848 x 848 pixels · Davis DR grading
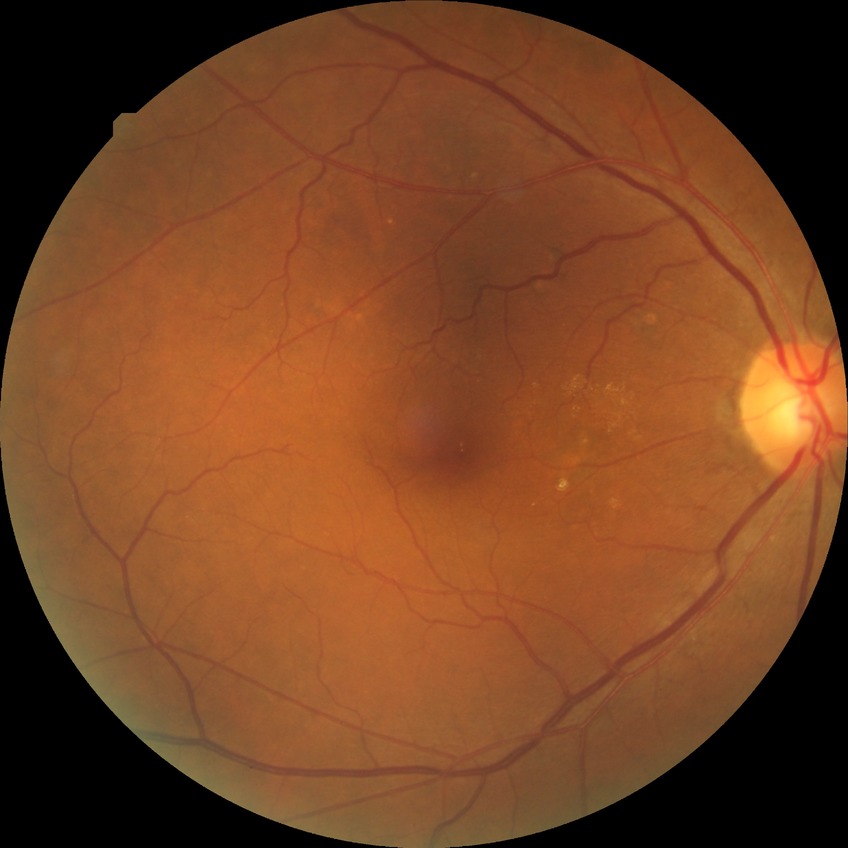
Diabetic retinopathy (DR) is no diabetic retinopathy (NDR).